Image size 2352x1568.
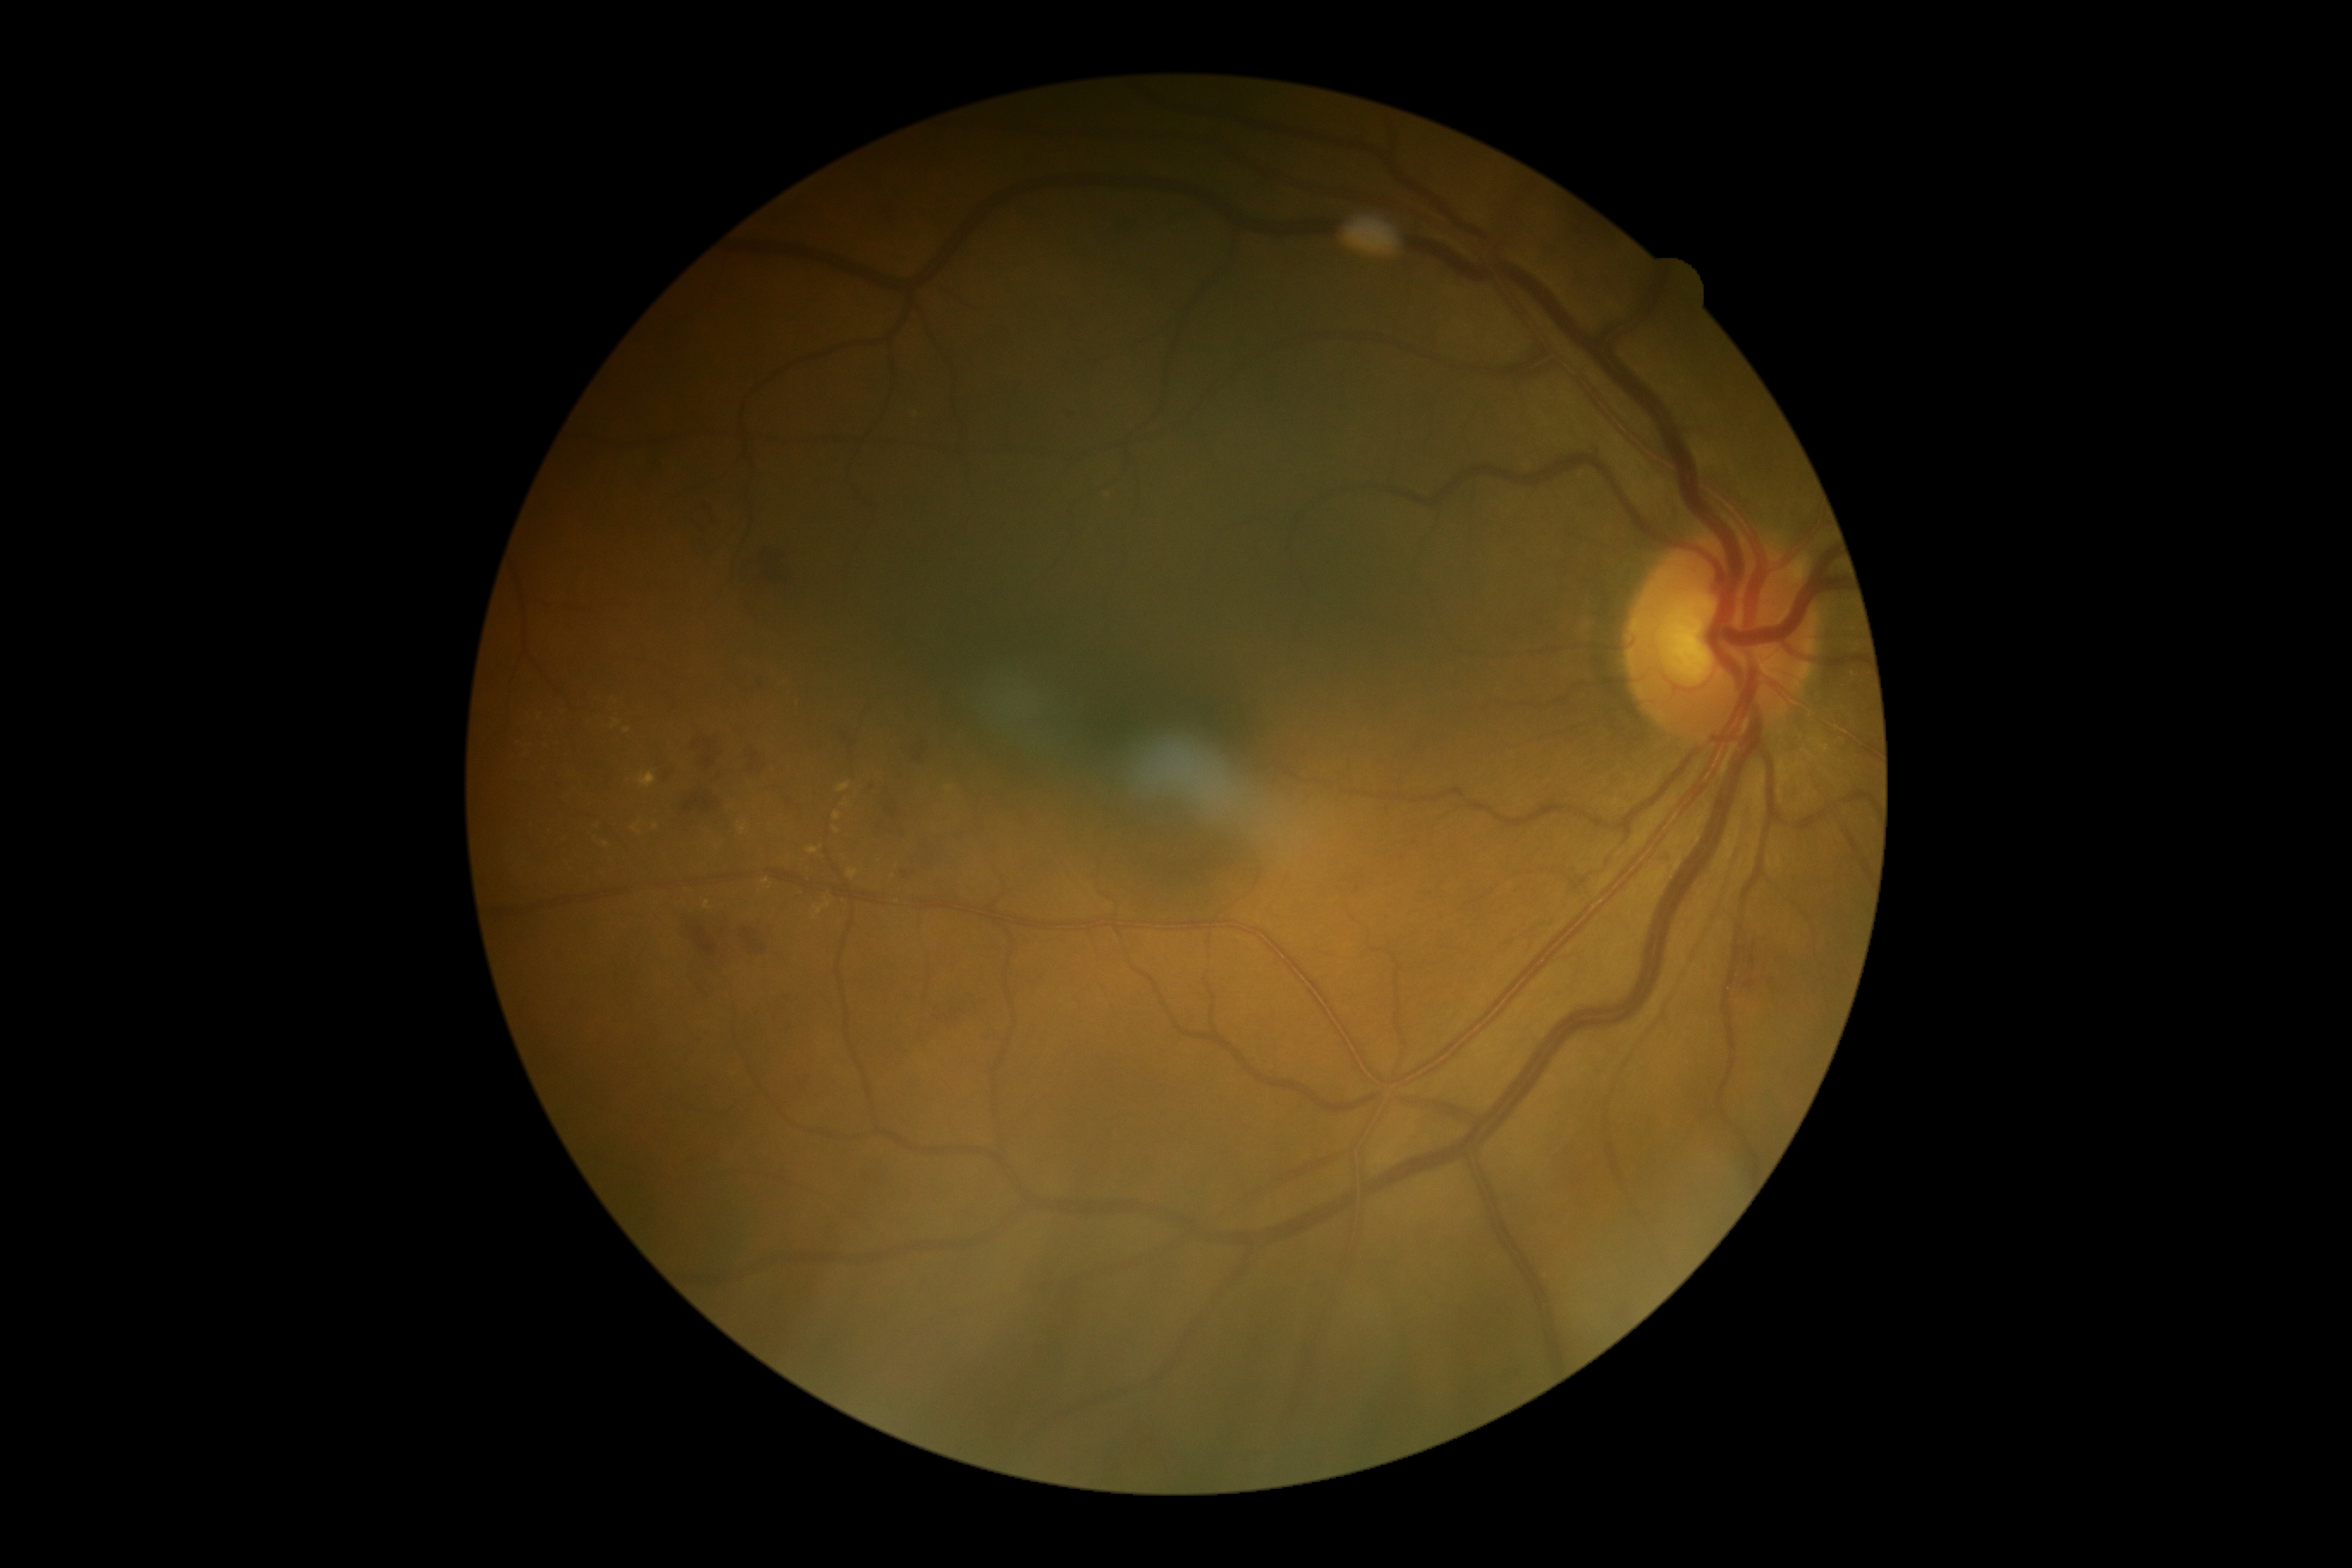 partial: true
dr_grade: 2
dr_grade_name: moderate NPDR
lesions:
  he:
    - (687, 924, 721, 959)
    - (907, 733, 945, 768)
    - (757, 945, 768, 953)
    - (716, 929, 726, 940)
    - (900, 845, 943, 883)
    - (945, 1008, 959, 1022)
    - (702, 513, 714, 553)
    - (1741, 941, 1761, 993)
    - (874, 781, 907, 835)
    - (680, 792, 720, 814)
    - (658, 747, 670, 781)
    - (749, 754, 761, 771)
    - (694, 738, 718, 769)
    - (828, 732, 843, 742)
    - (745, 560, 790, 604)
    - (740, 928, 759, 950)
  he_small:
    - (1771; 984)
    - (849; 745)
  se: []
  ex:
    - (639, 773, 656, 788)
    - (835, 812, 842, 821)
    - (632, 823, 640, 831)
    - (704, 902, 709, 910)
    - (738, 823, 747, 835)
    - (838, 783, 850, 793)
    - (814, 903, 831, 916)
    - (807, 847, 823, 855)
    - (611, 721, 620, 730)
    - (848, 869, 859, 879)
  ex_small:
    - (606; 845)
    - (656; 827)
    - (836; 829)
    - (844; 805)
    - (626; 731)
    - (766; 882)